Color fundus photograph · 2352 x 1568 pixels · 45° FOV — 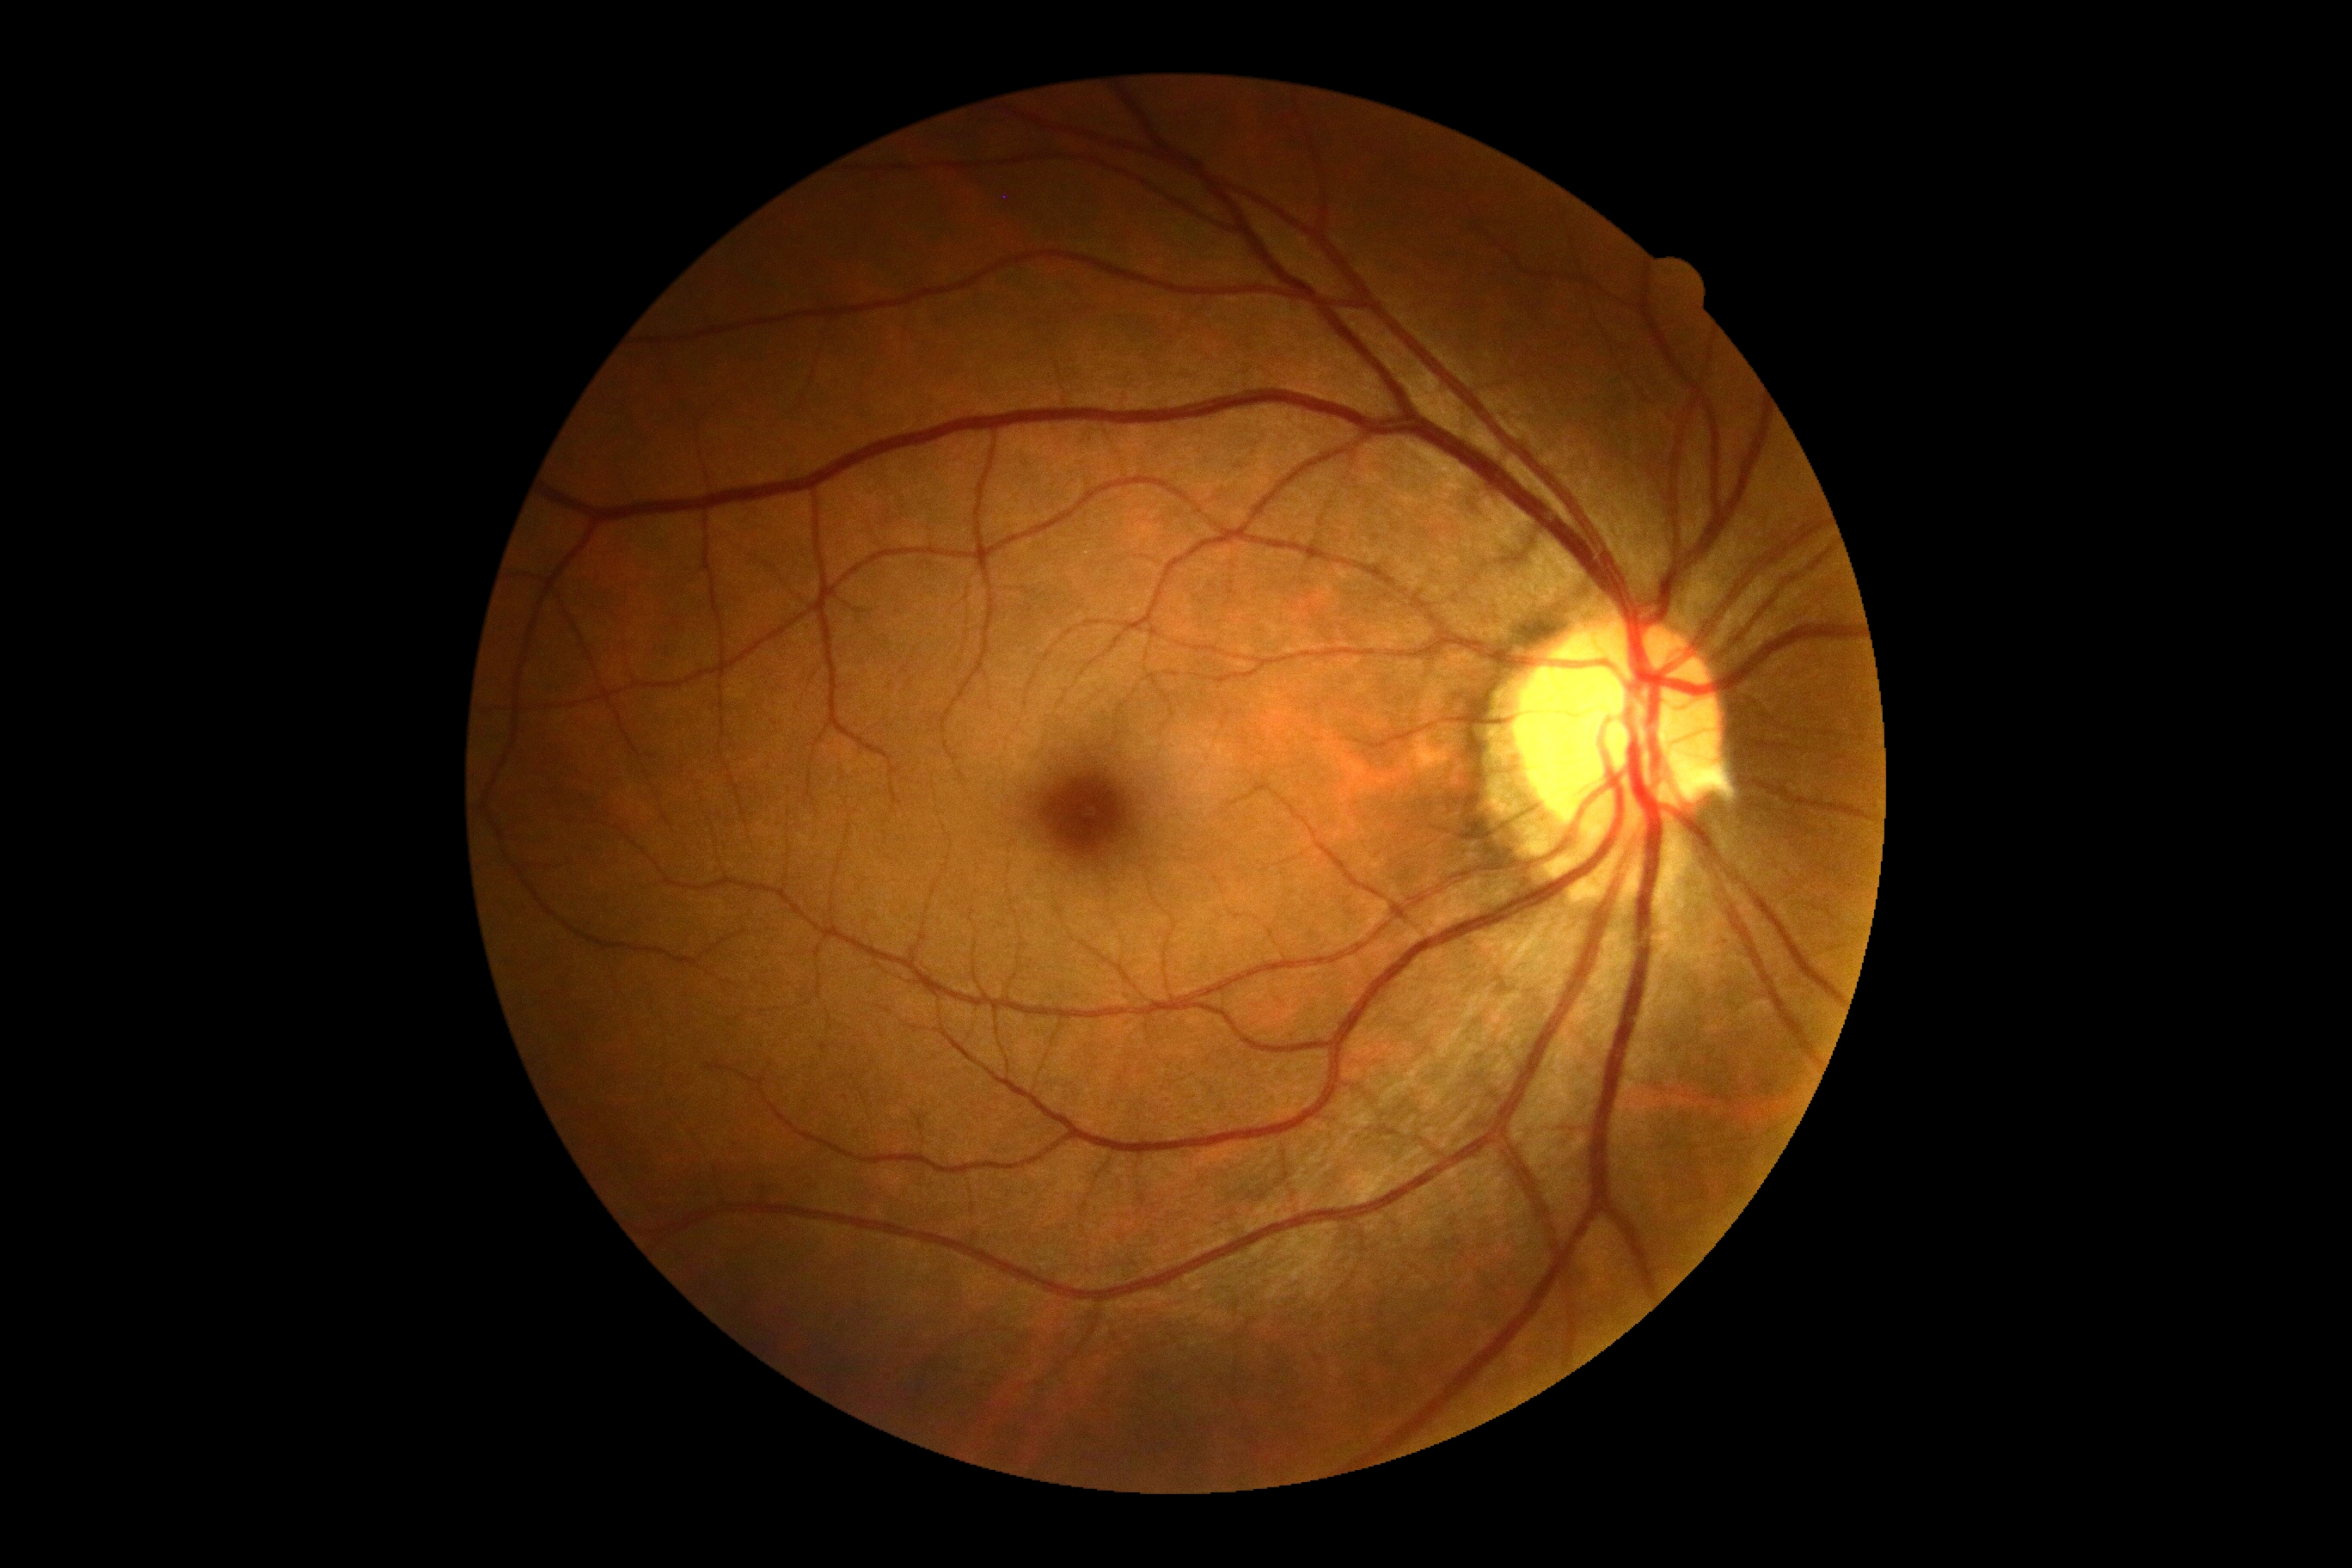

diabetic retinopathy severity=grade 0.